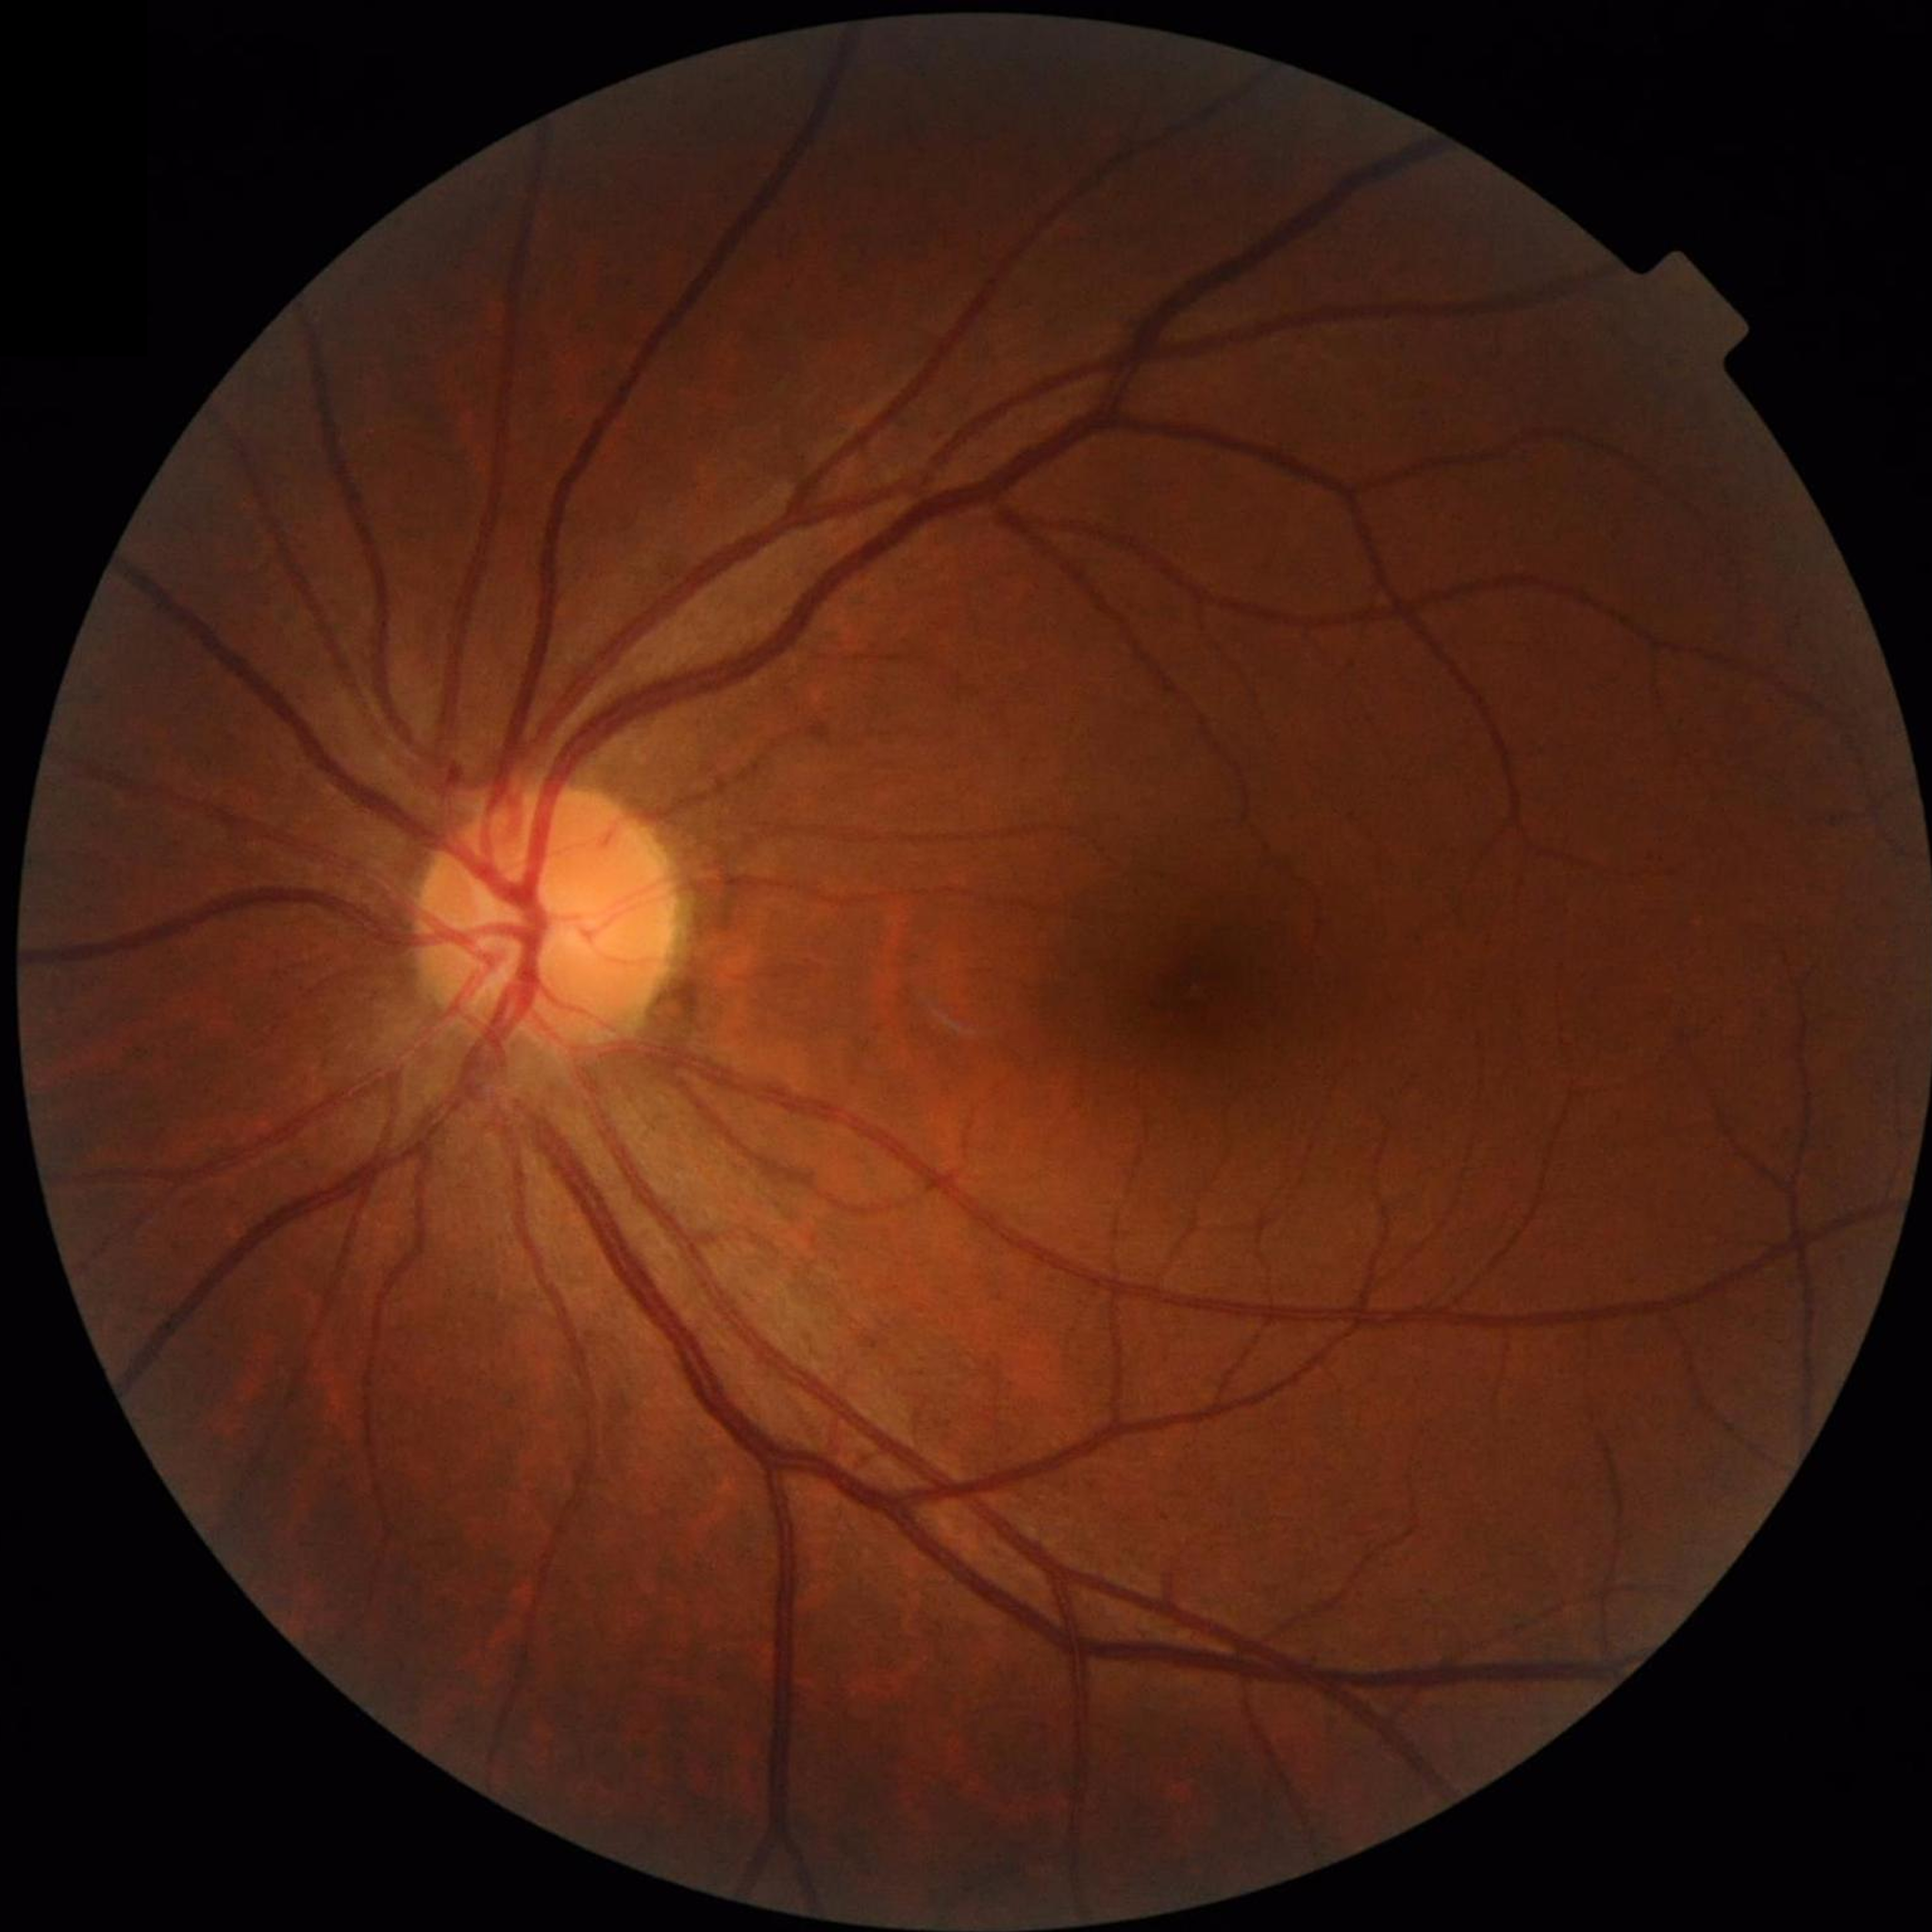

No findings of AMD, diabetic retinopathy, or glaucoma.